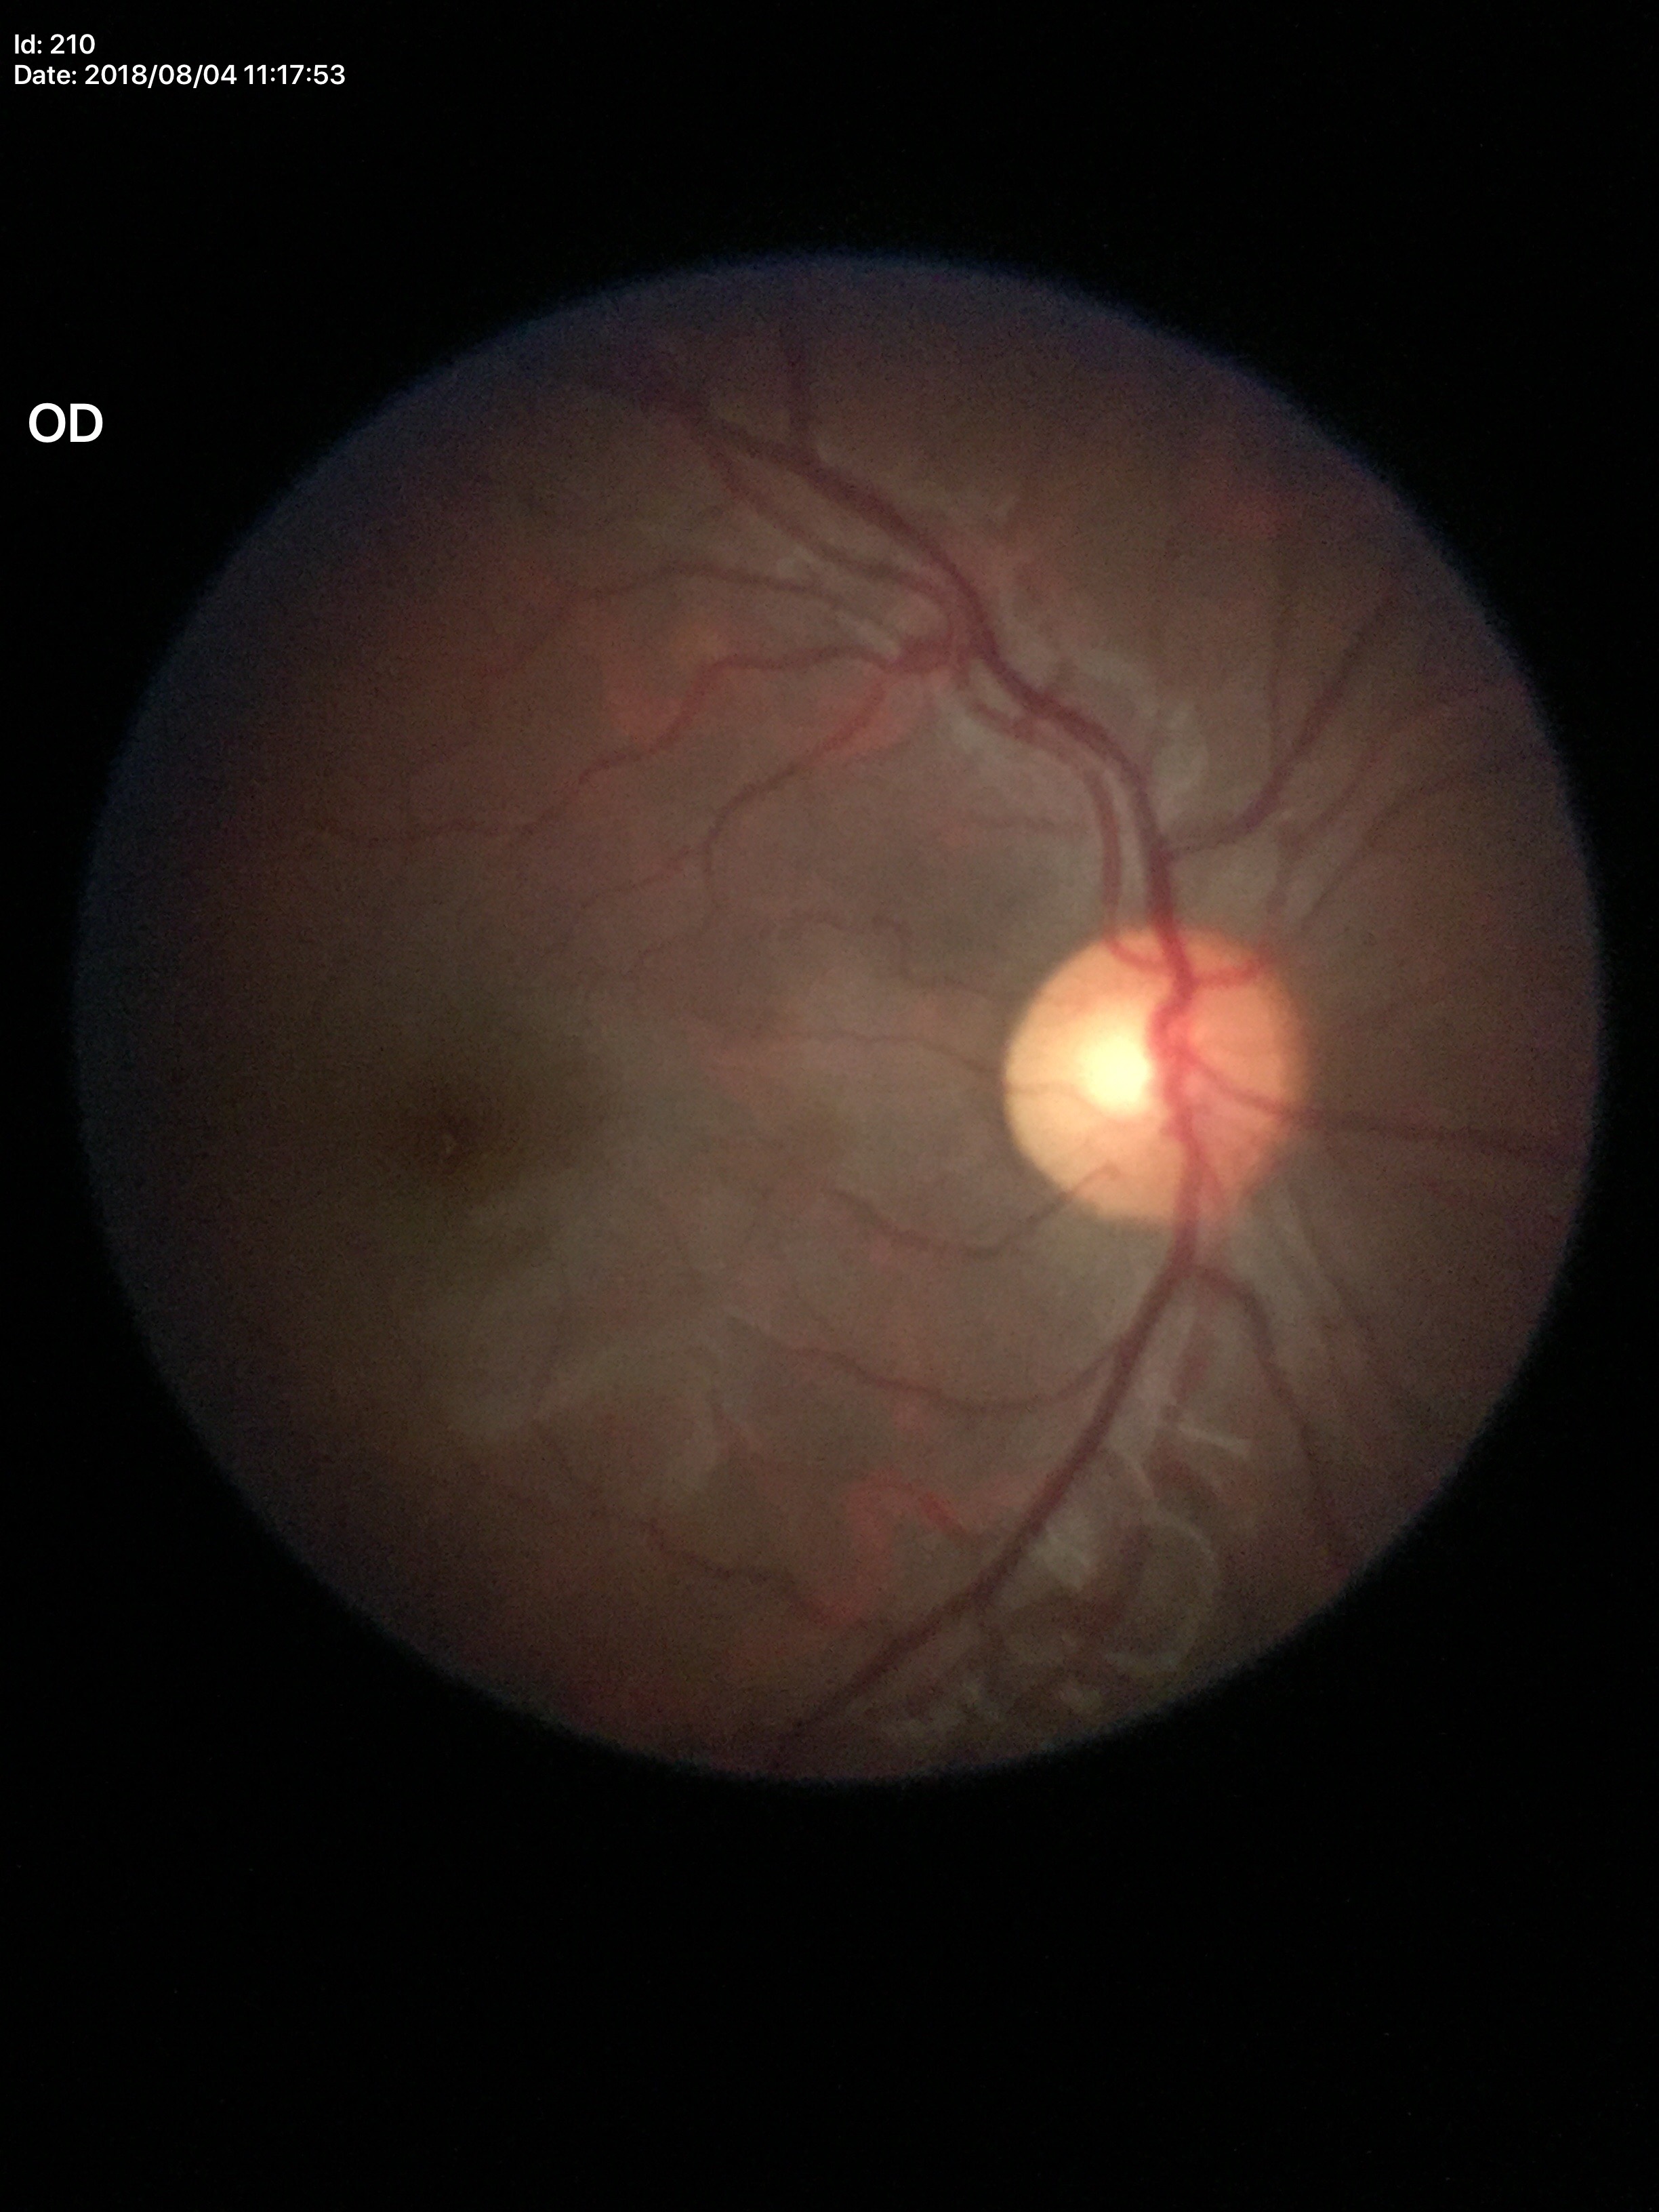
Glaucoma evaluation: negative (one of five ophthalmologists flagged glaucoma suspect), vertical cup-to-disc ratio (VCDR): 0.54, area cup-to-disc ratio (ACDR): 0.31.